Color fundus image. Camera: NIDEK AFC-230. 45° field of view. Image size 848x848.
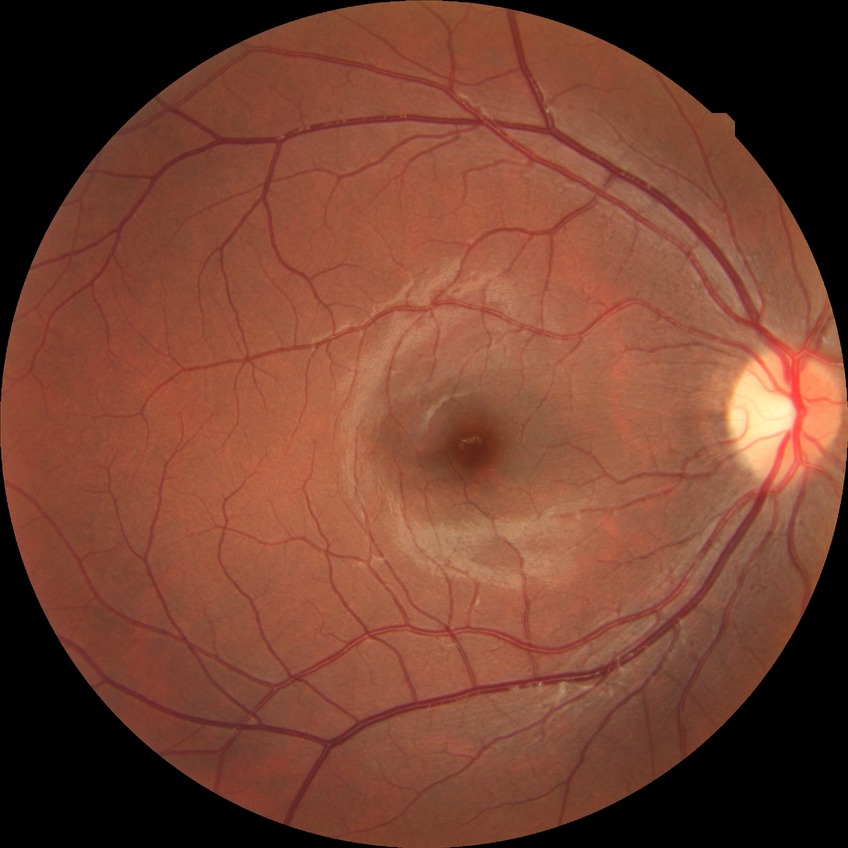
Diabetic retinopathy (DR) is NDR (no diabetic retinopathy).